Color fundus image. Image size 848x848. 45° field of view
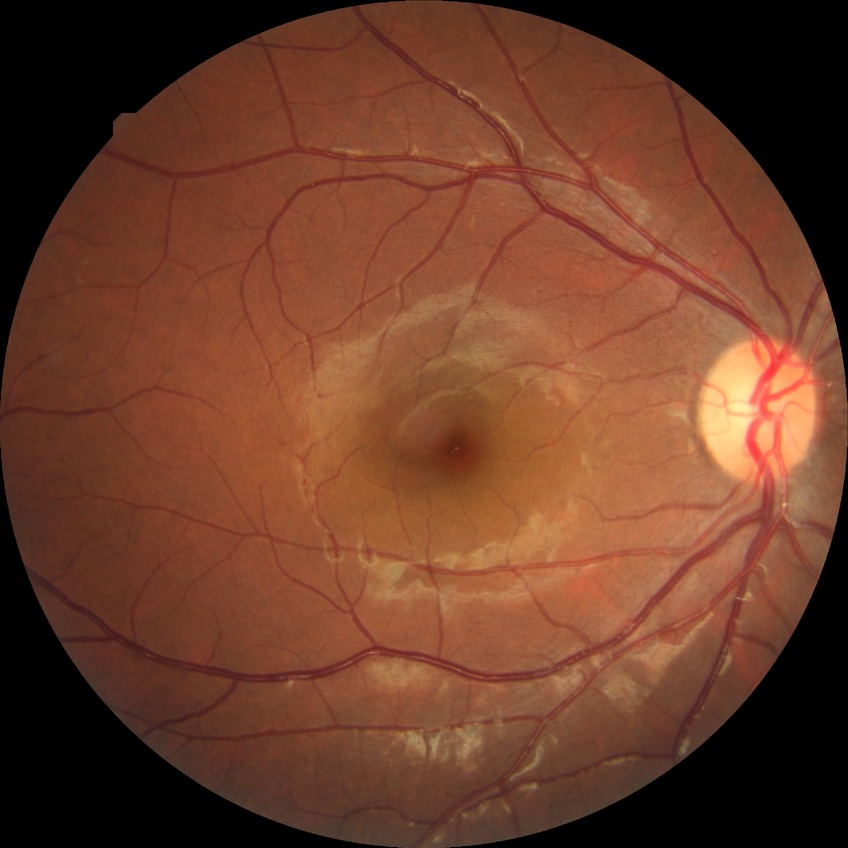 DR impression = negative for DR | Davis grade = NDR.